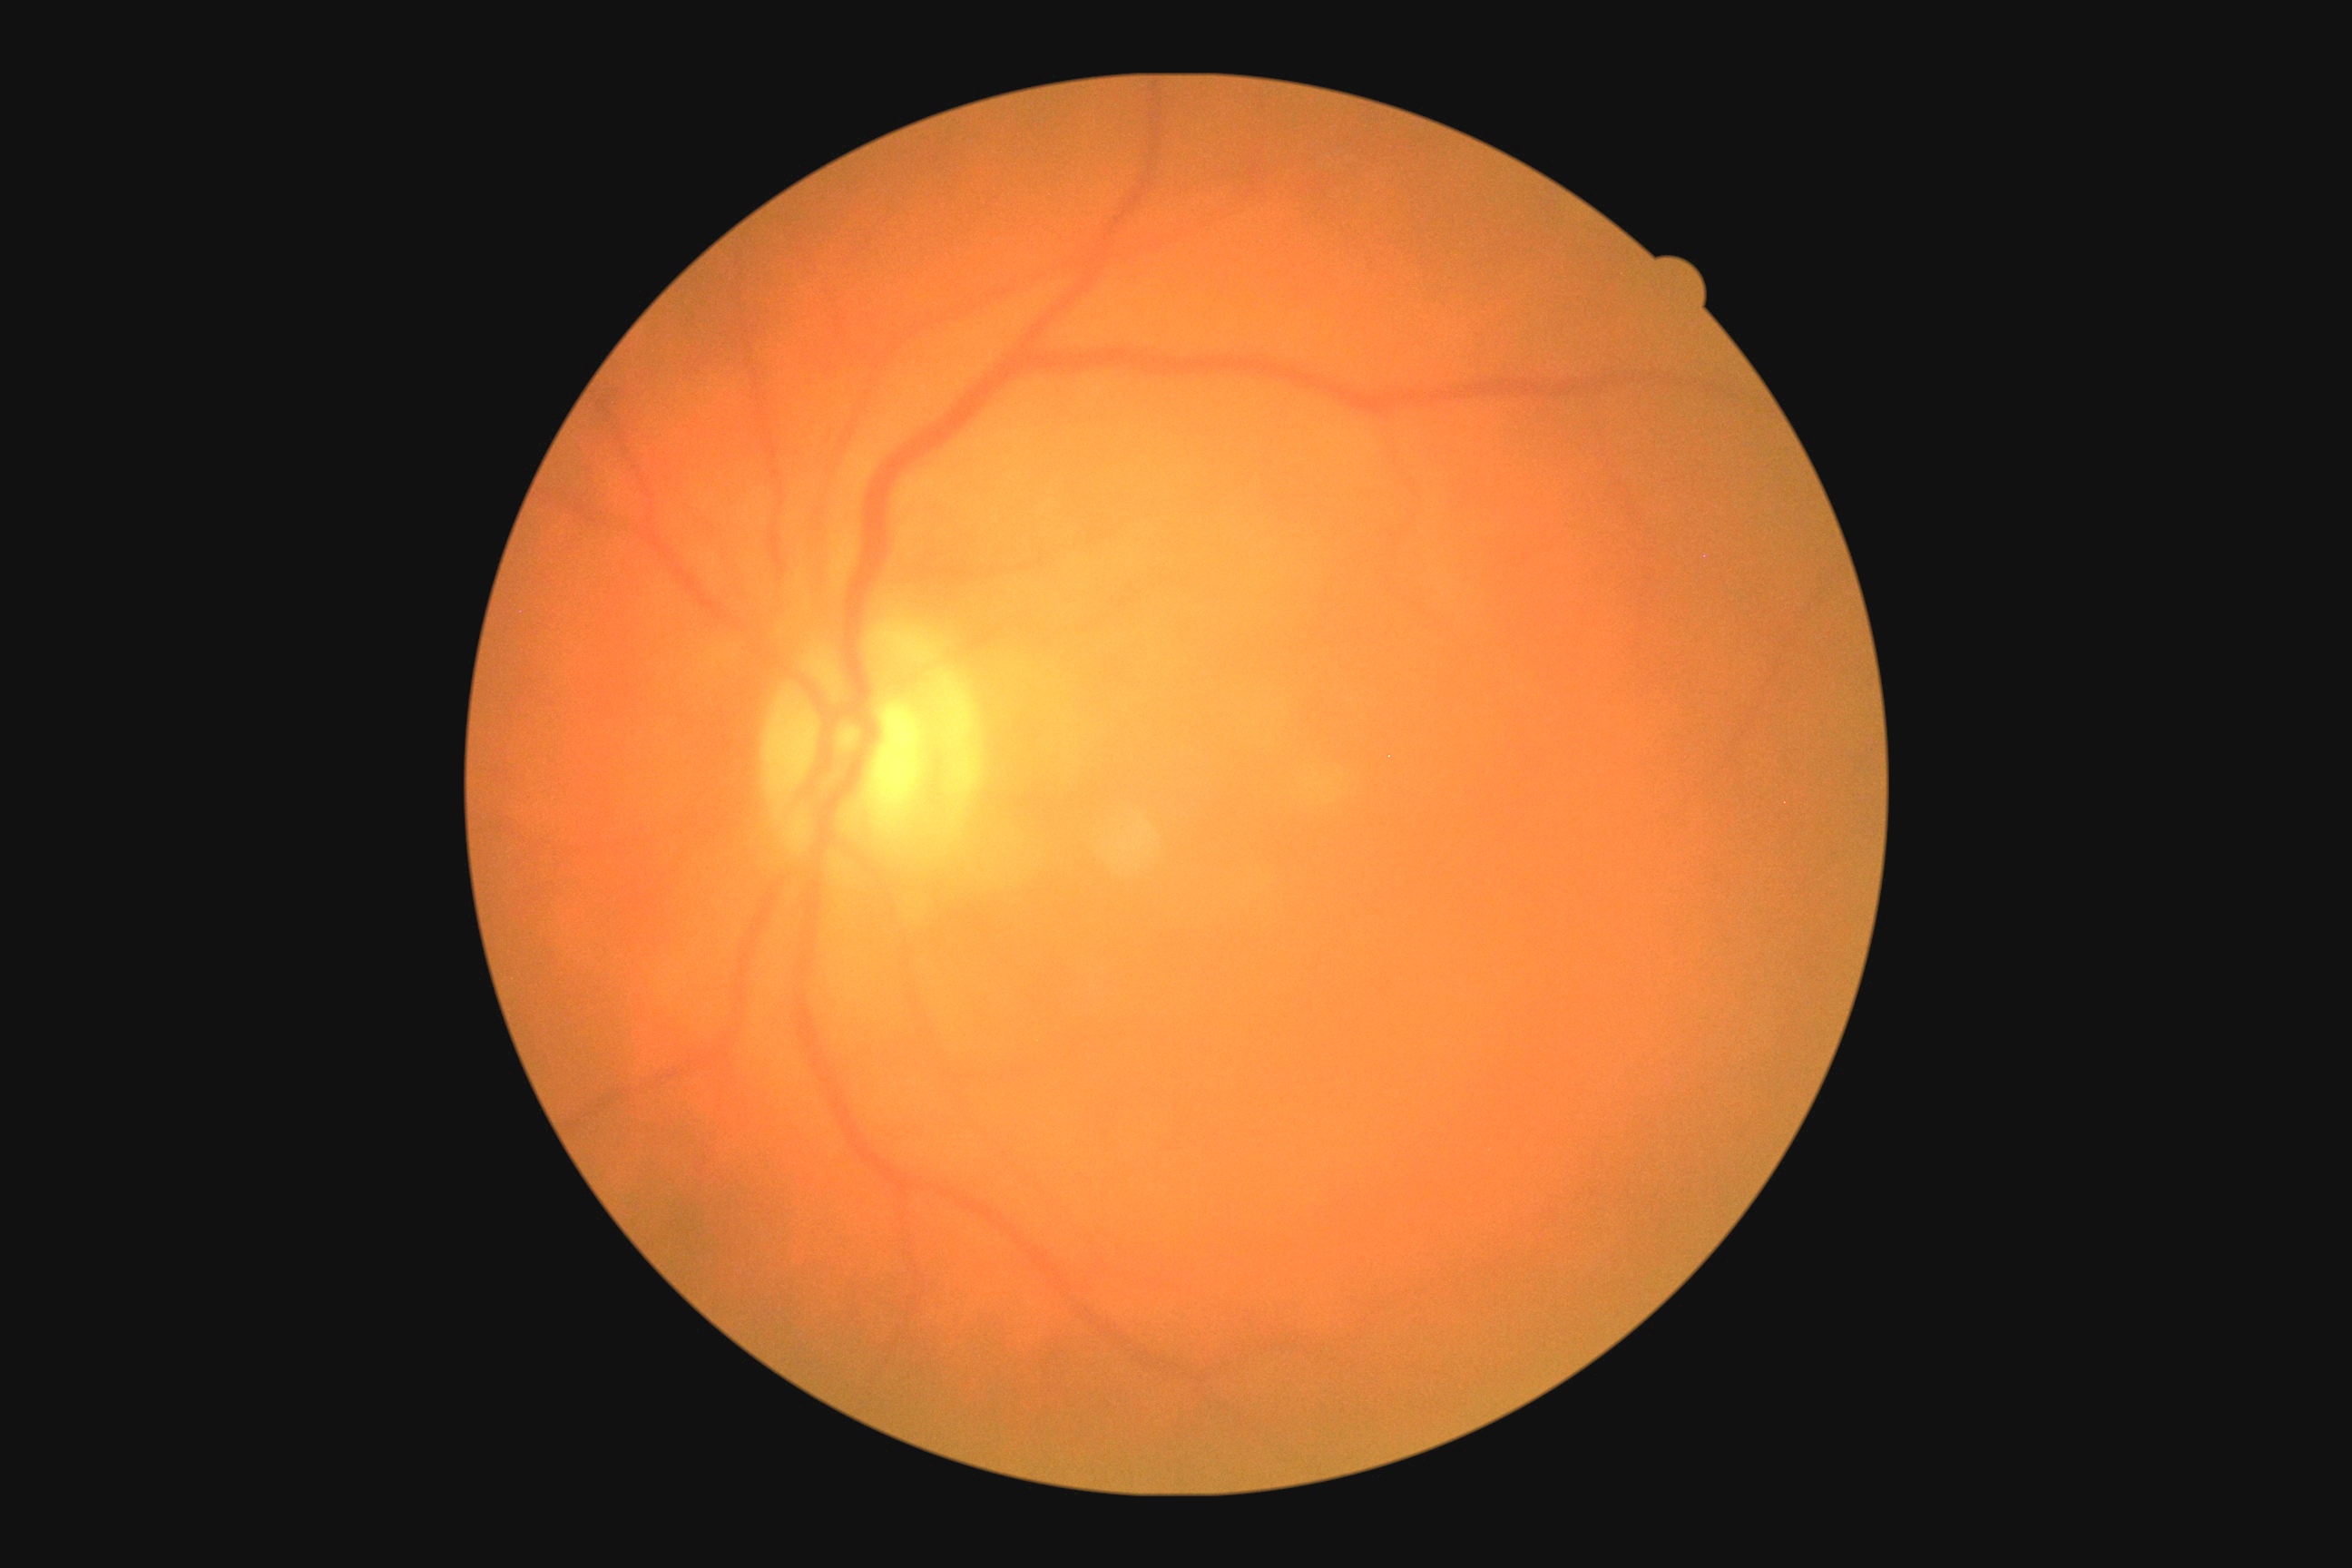
No DR findings. Diabetic retinopathy grade is 0.